FOV: 45 degrees. Fundus photo. Without pupil dilation:
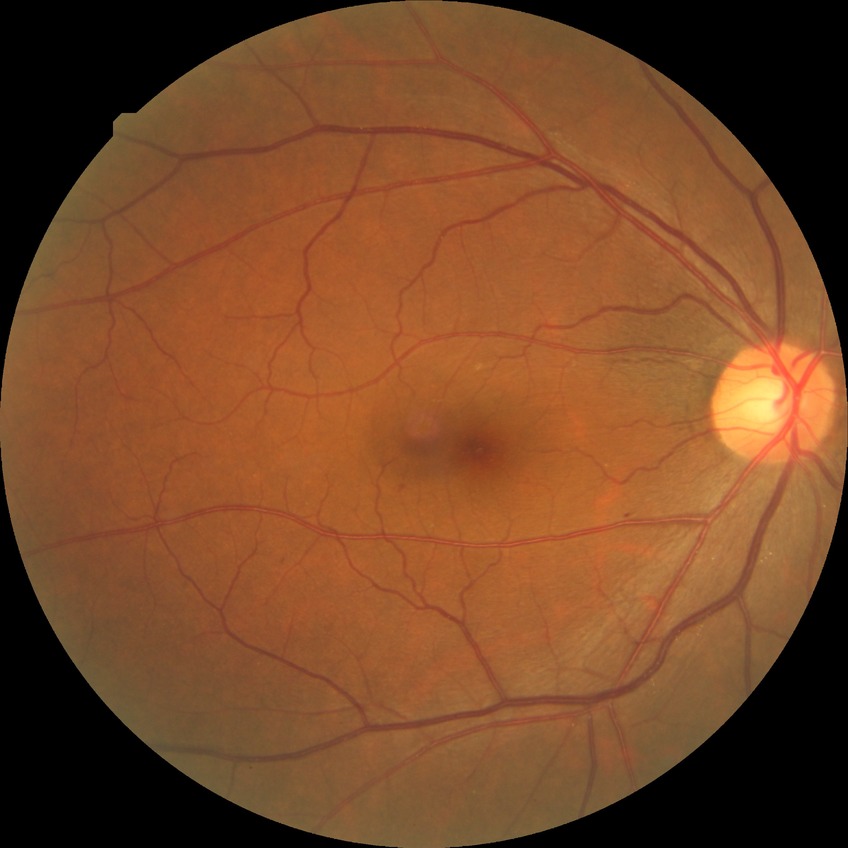
Assessment:
- retinopathy grade — simple diabetic retinopathy